Camera: Bosch fundus camera.
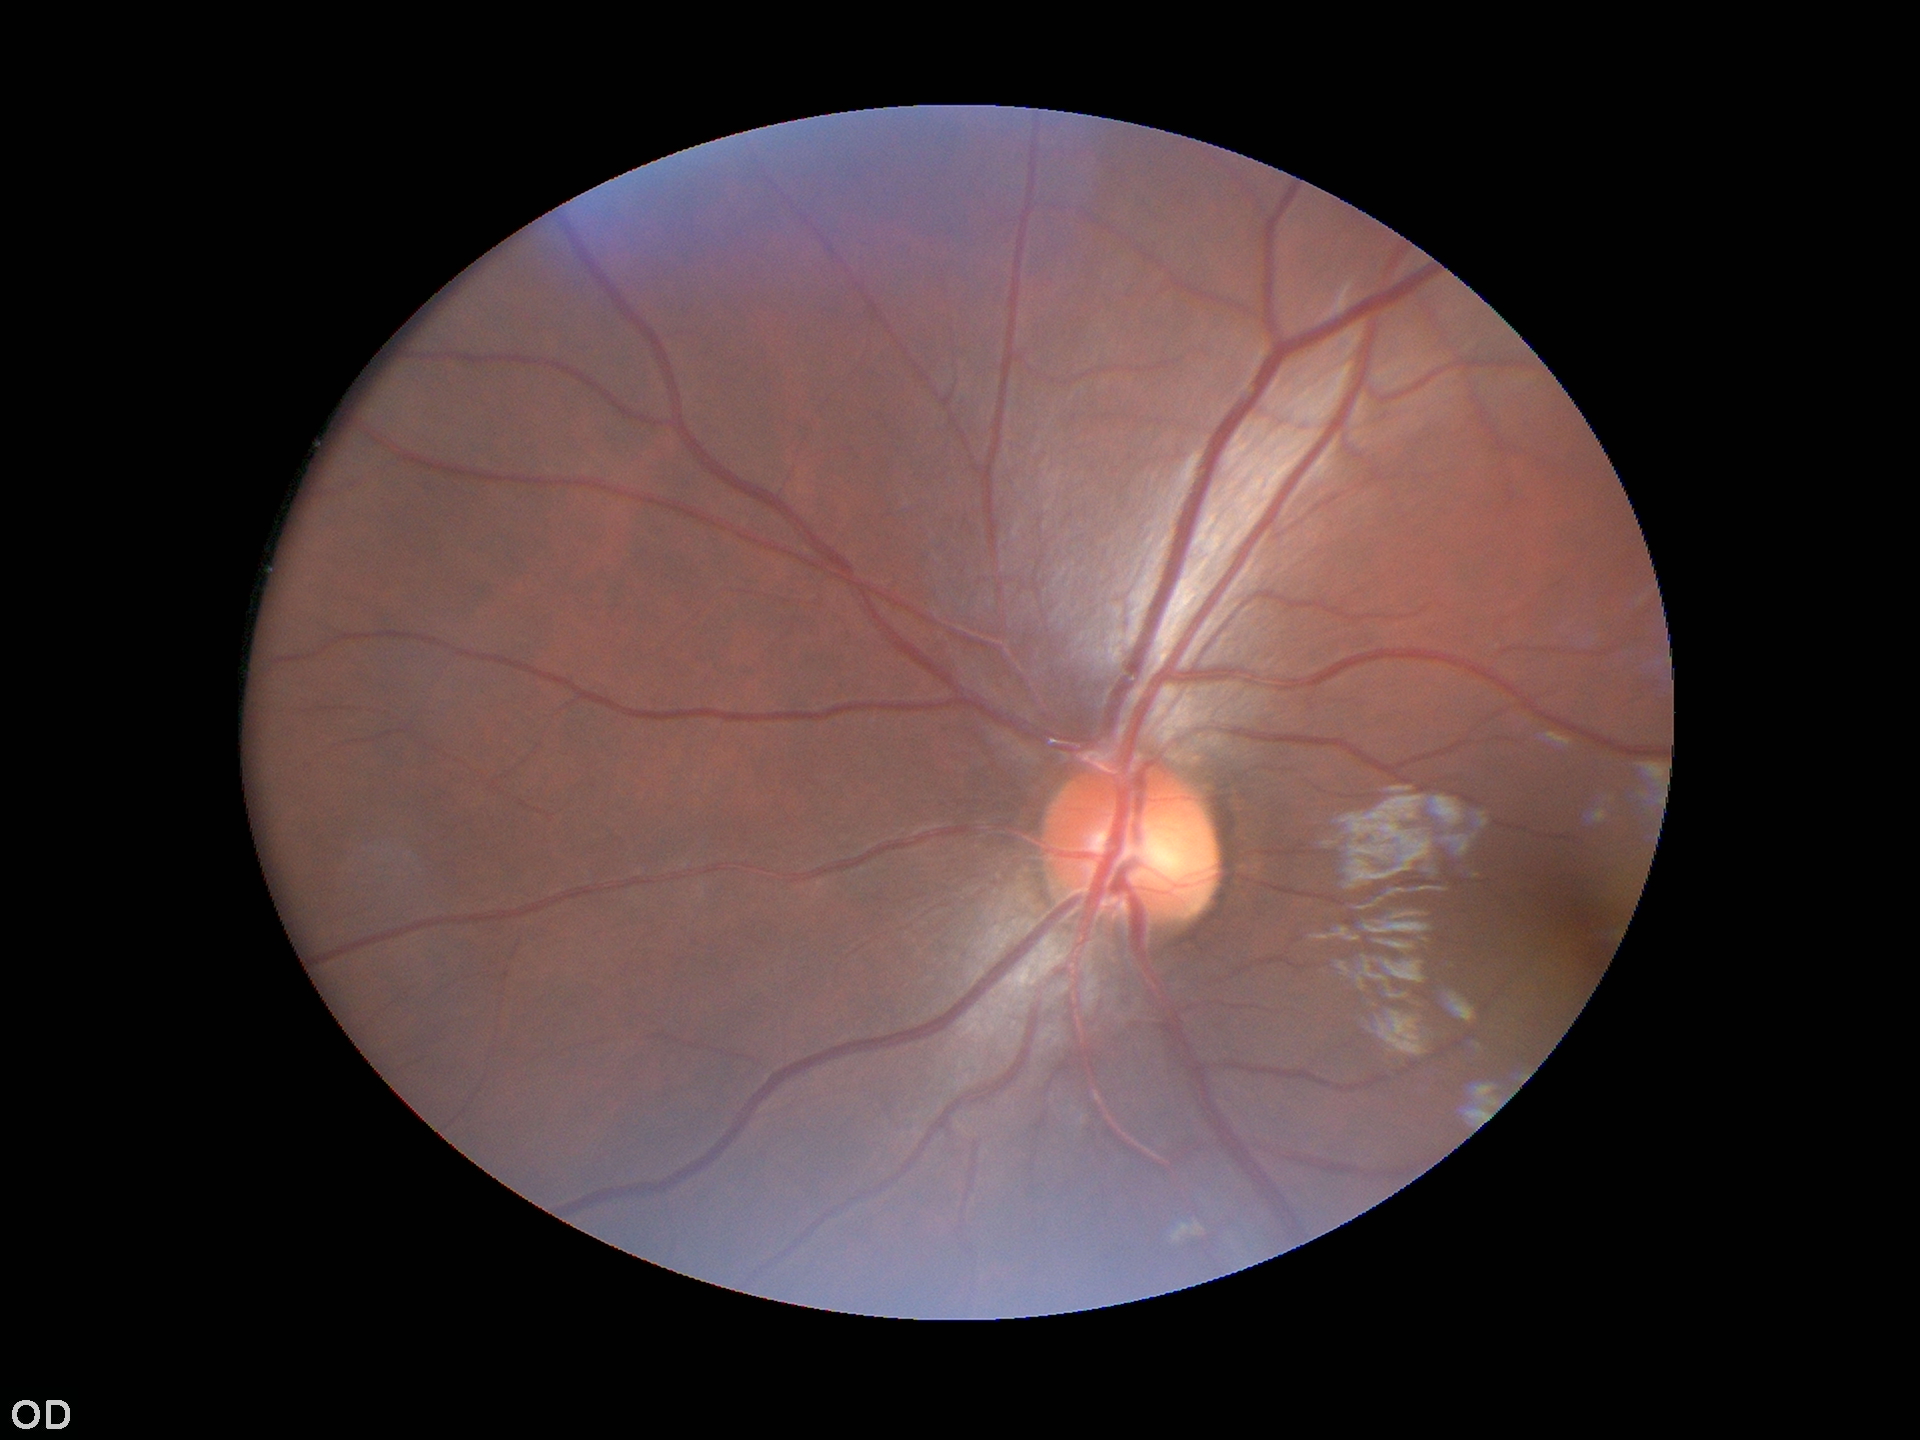

No evidence of glaucoma. Vertical CDR (VCDR): 0.44. Horizontal cup-to-disc ratio (HCDR) is 0.48.